200° field of view; ultra-widefield fundus photograph — 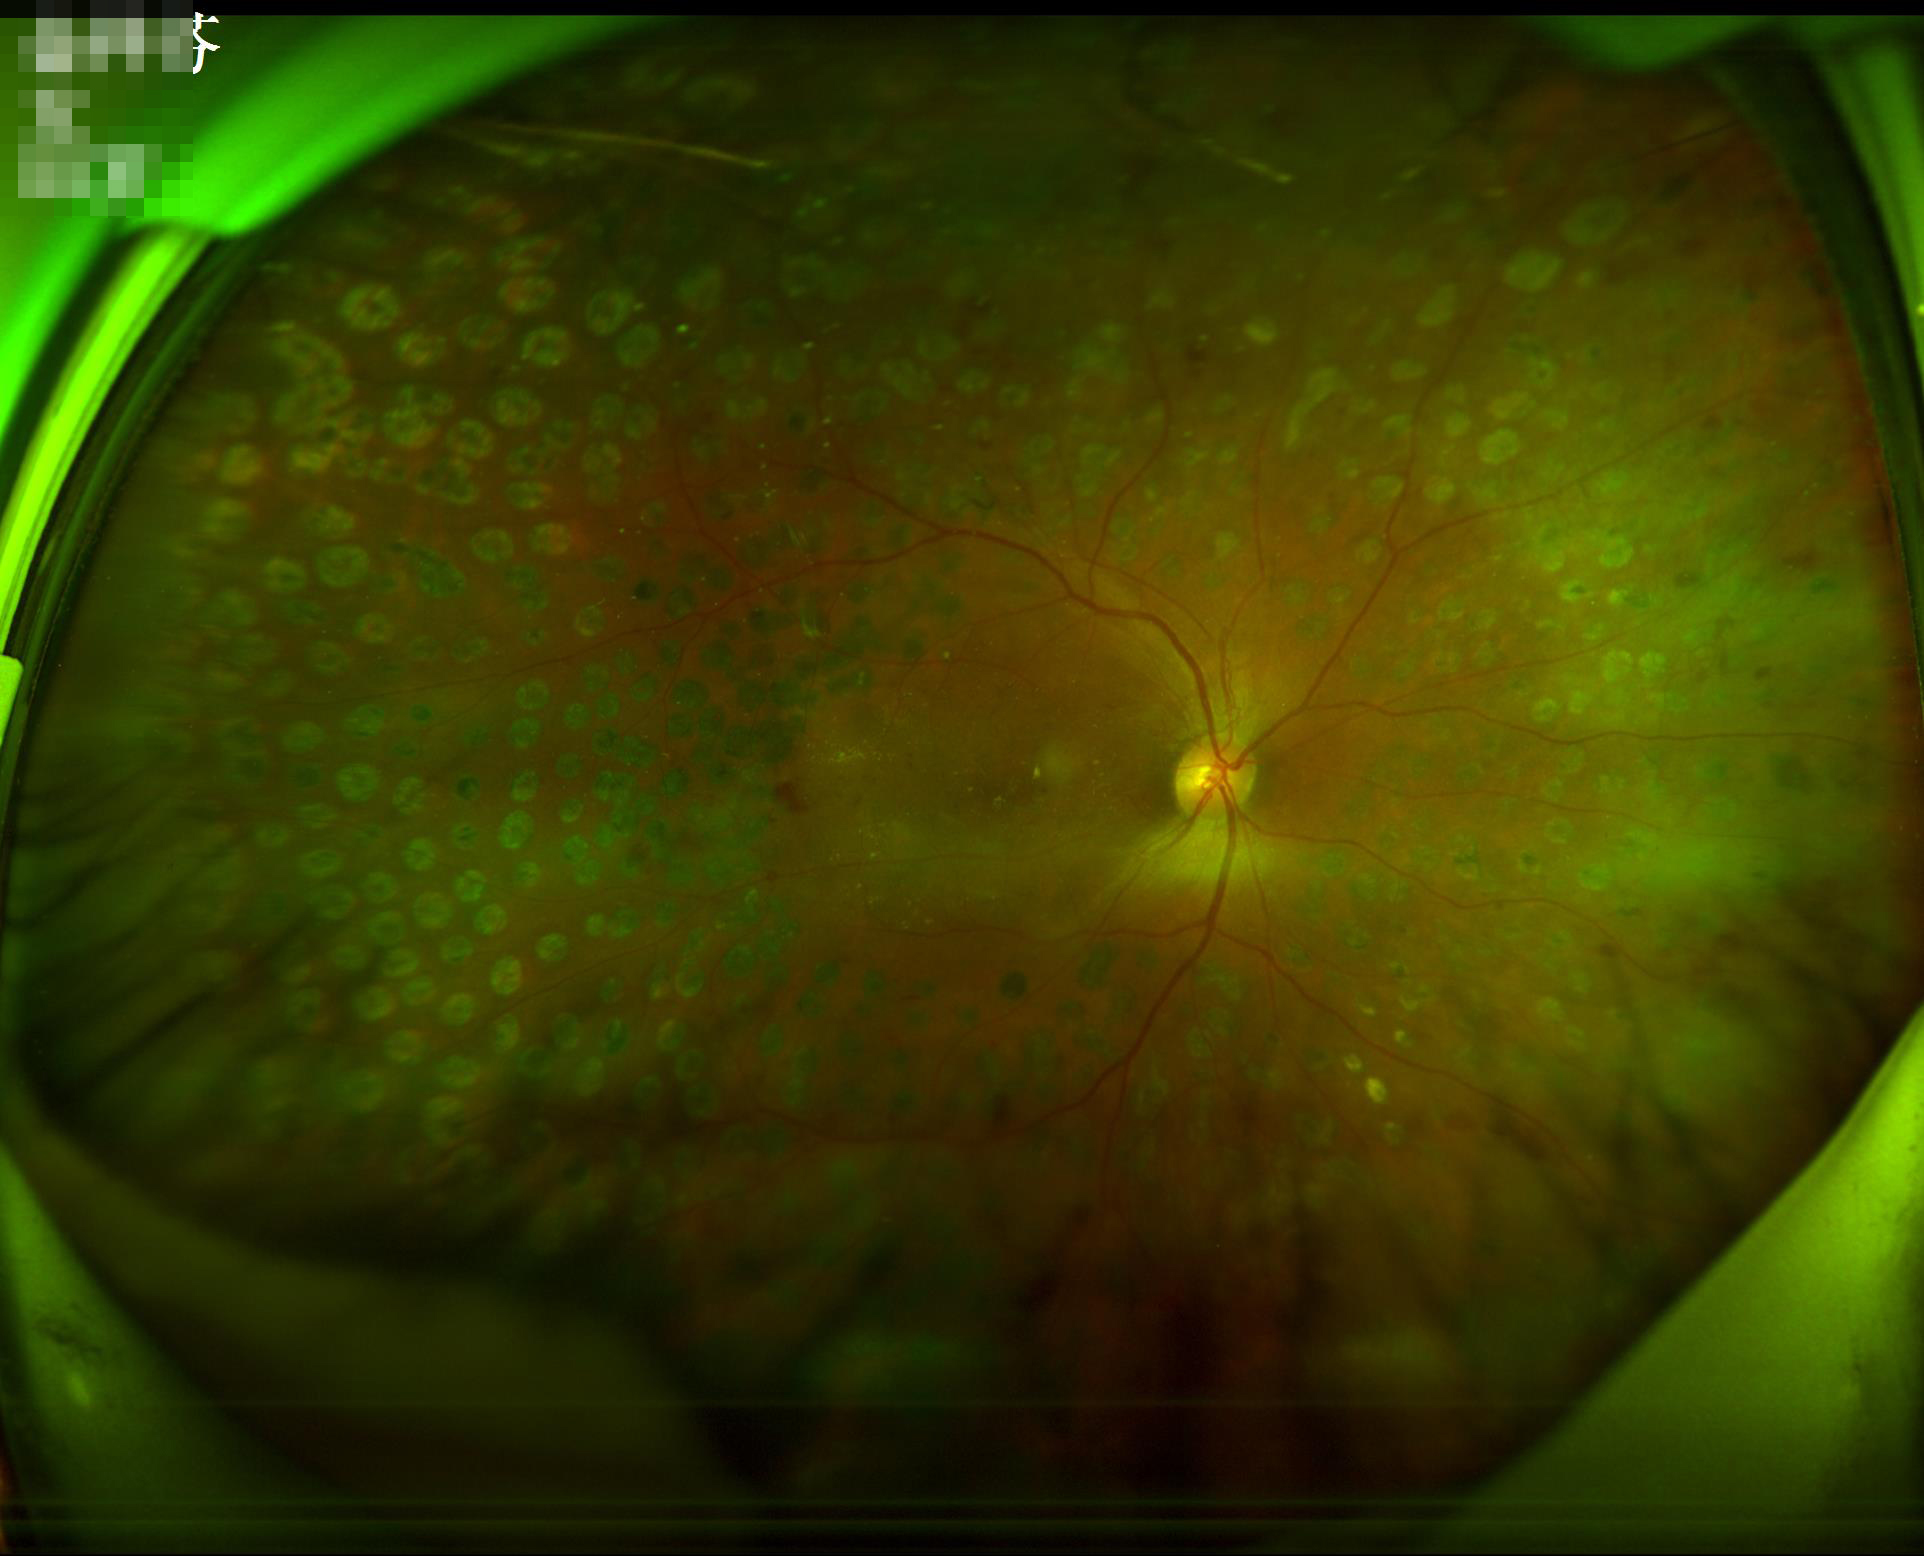
The image is clear.
Acceptable image quality.
No over- or under-exposure.